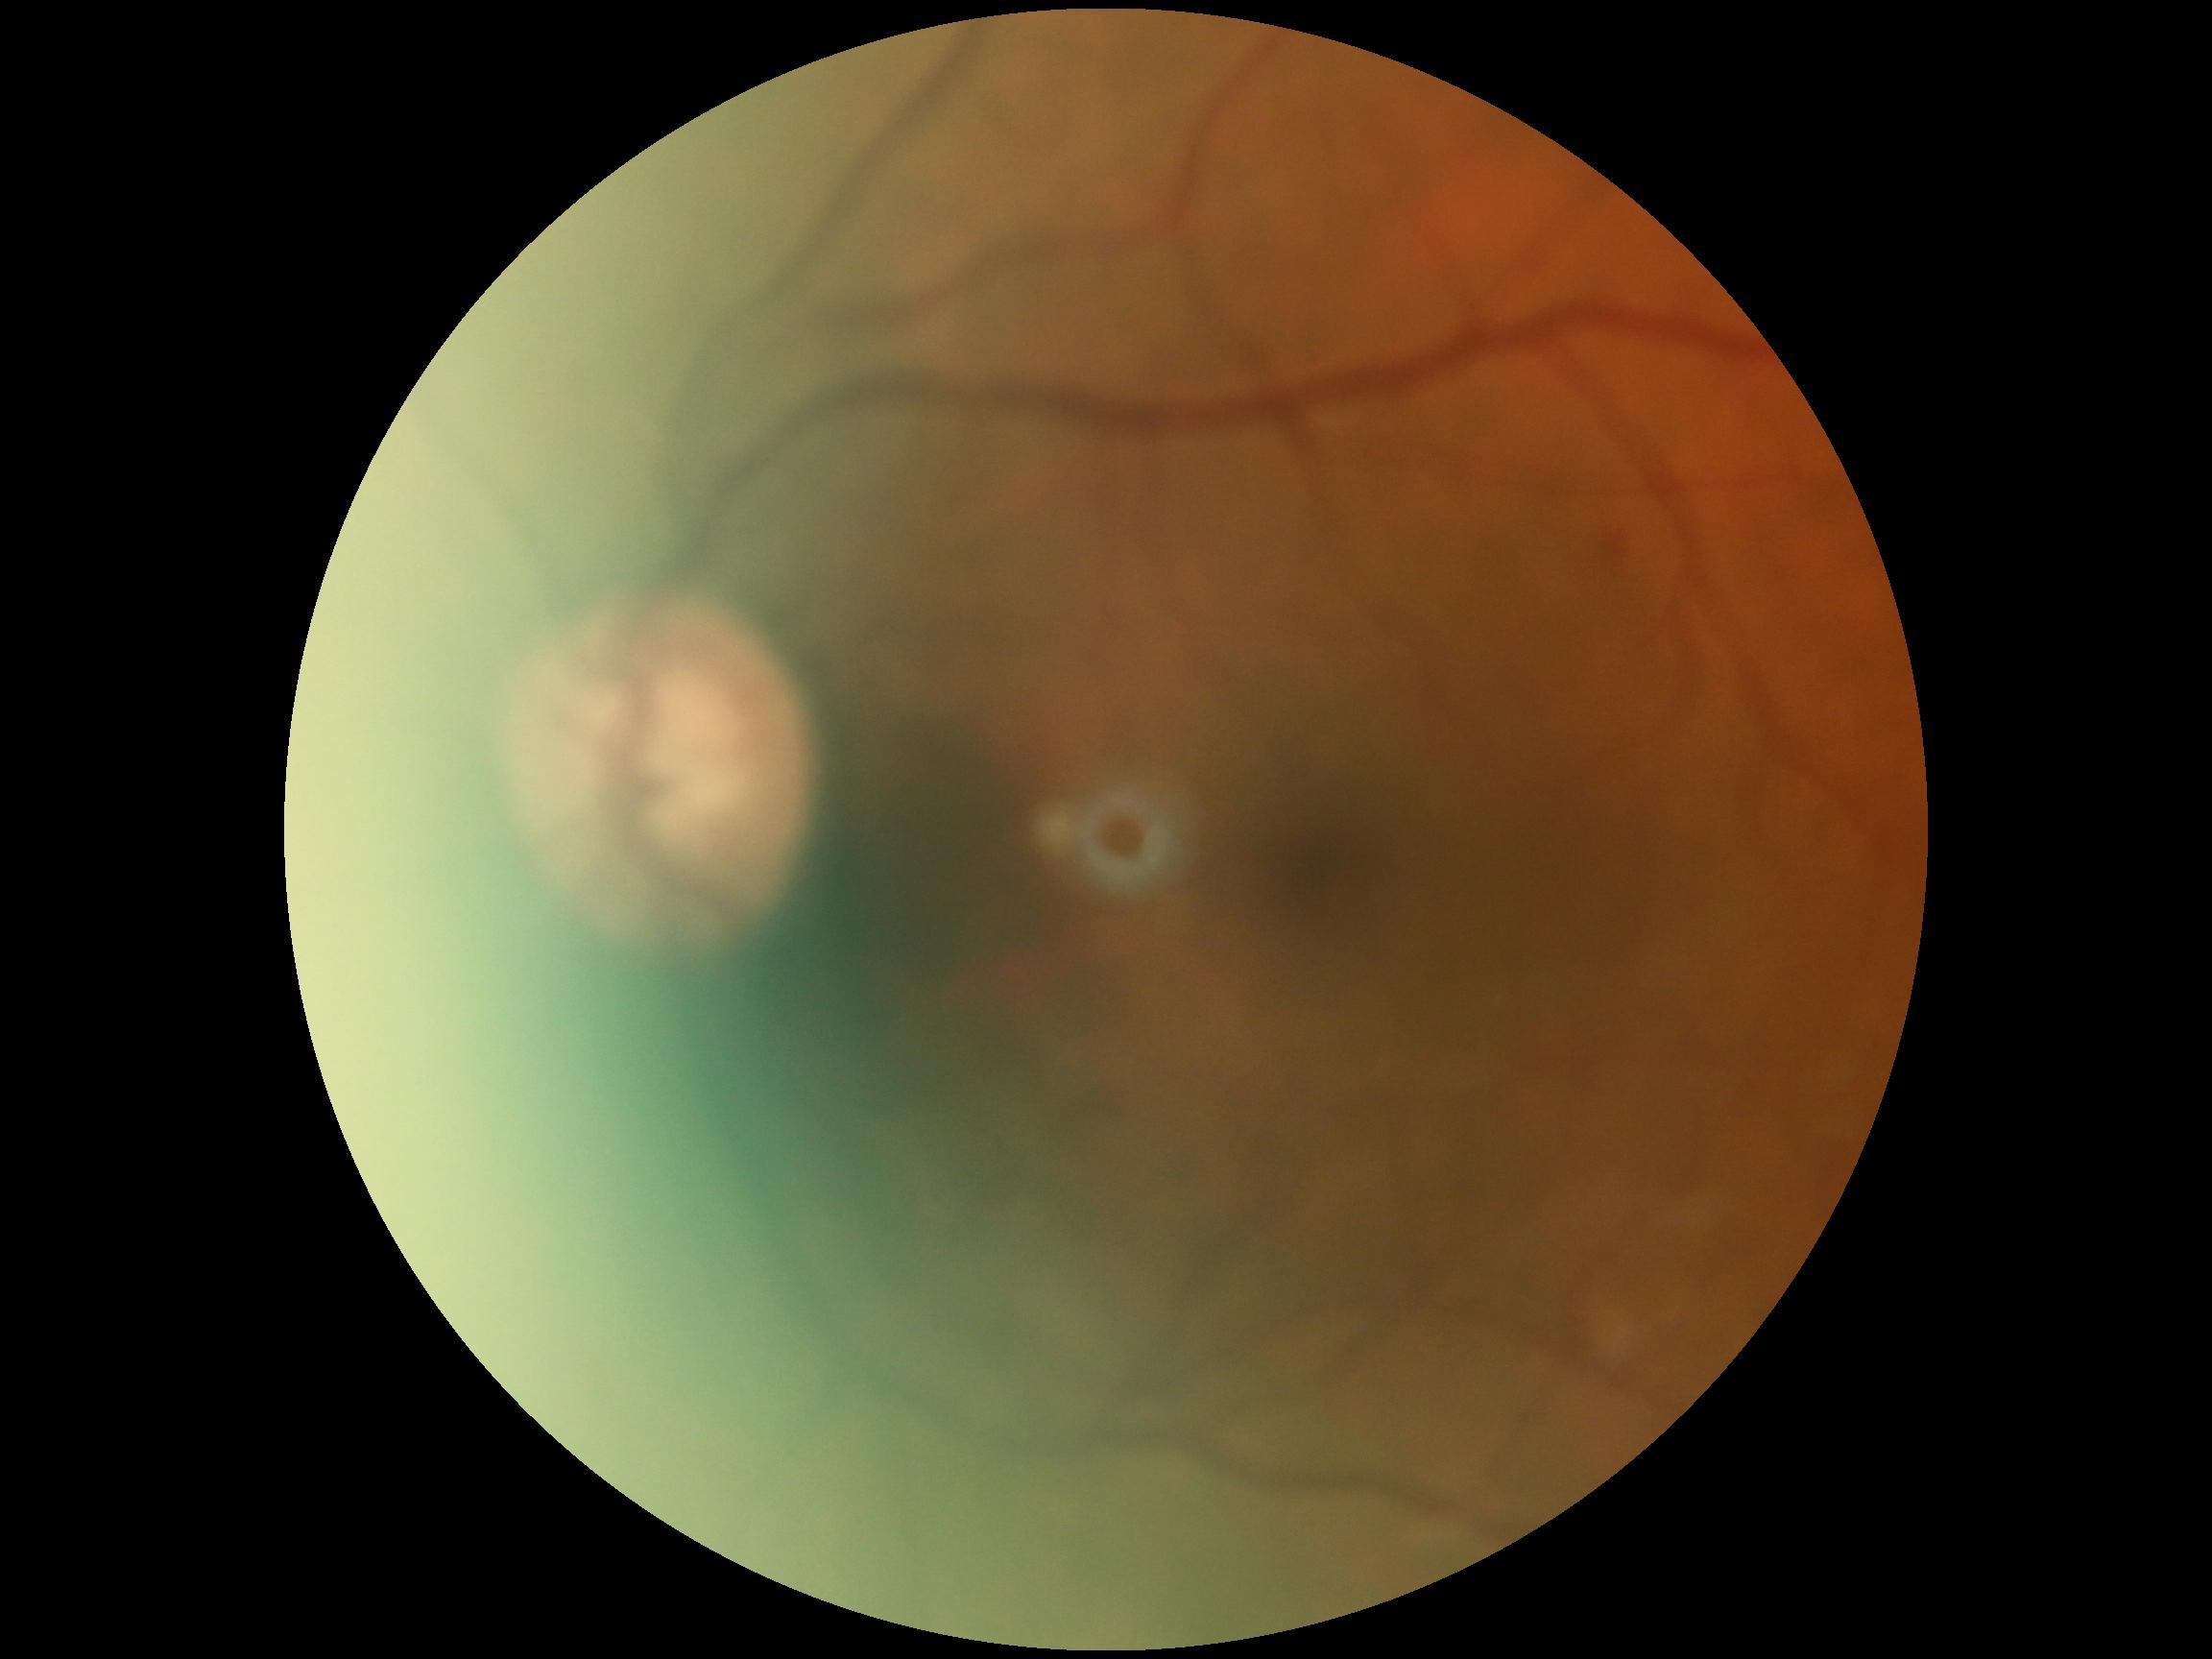 diabetic retinopathy (DR): grade 2 (moderate NPDR)